Retinal fundus photograph · nonmydriatic · NIDEK AFC-230 fundus camera · 848 x 848 pixels · FOV: 45 degrees: 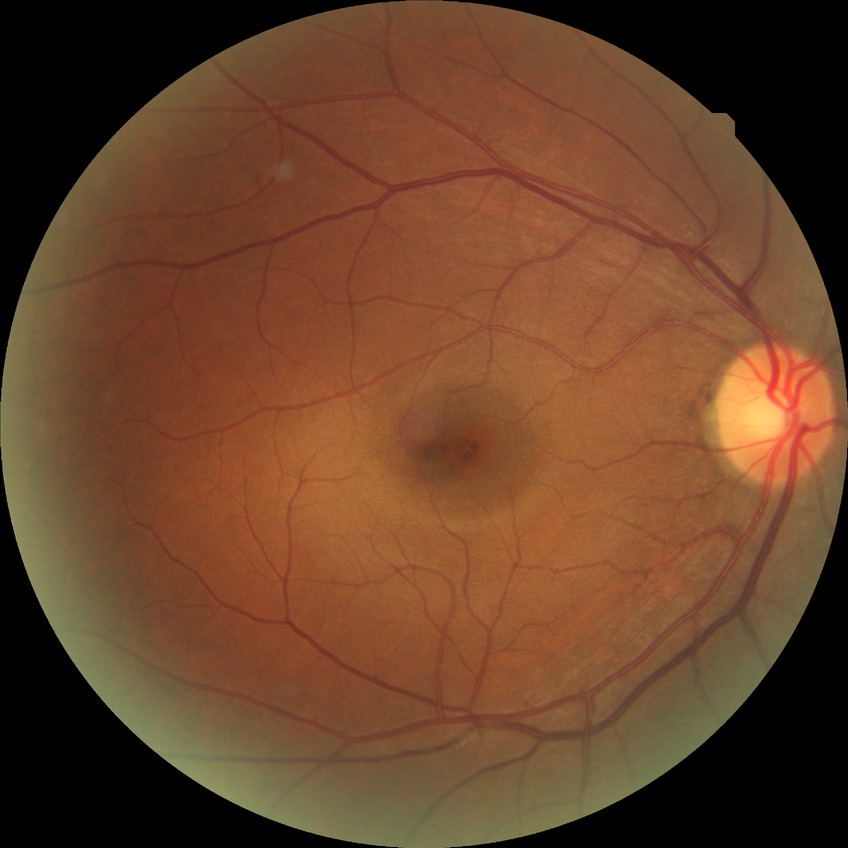 Diabetic retinopathy (DR): NDR (no diabetic retinopathy).